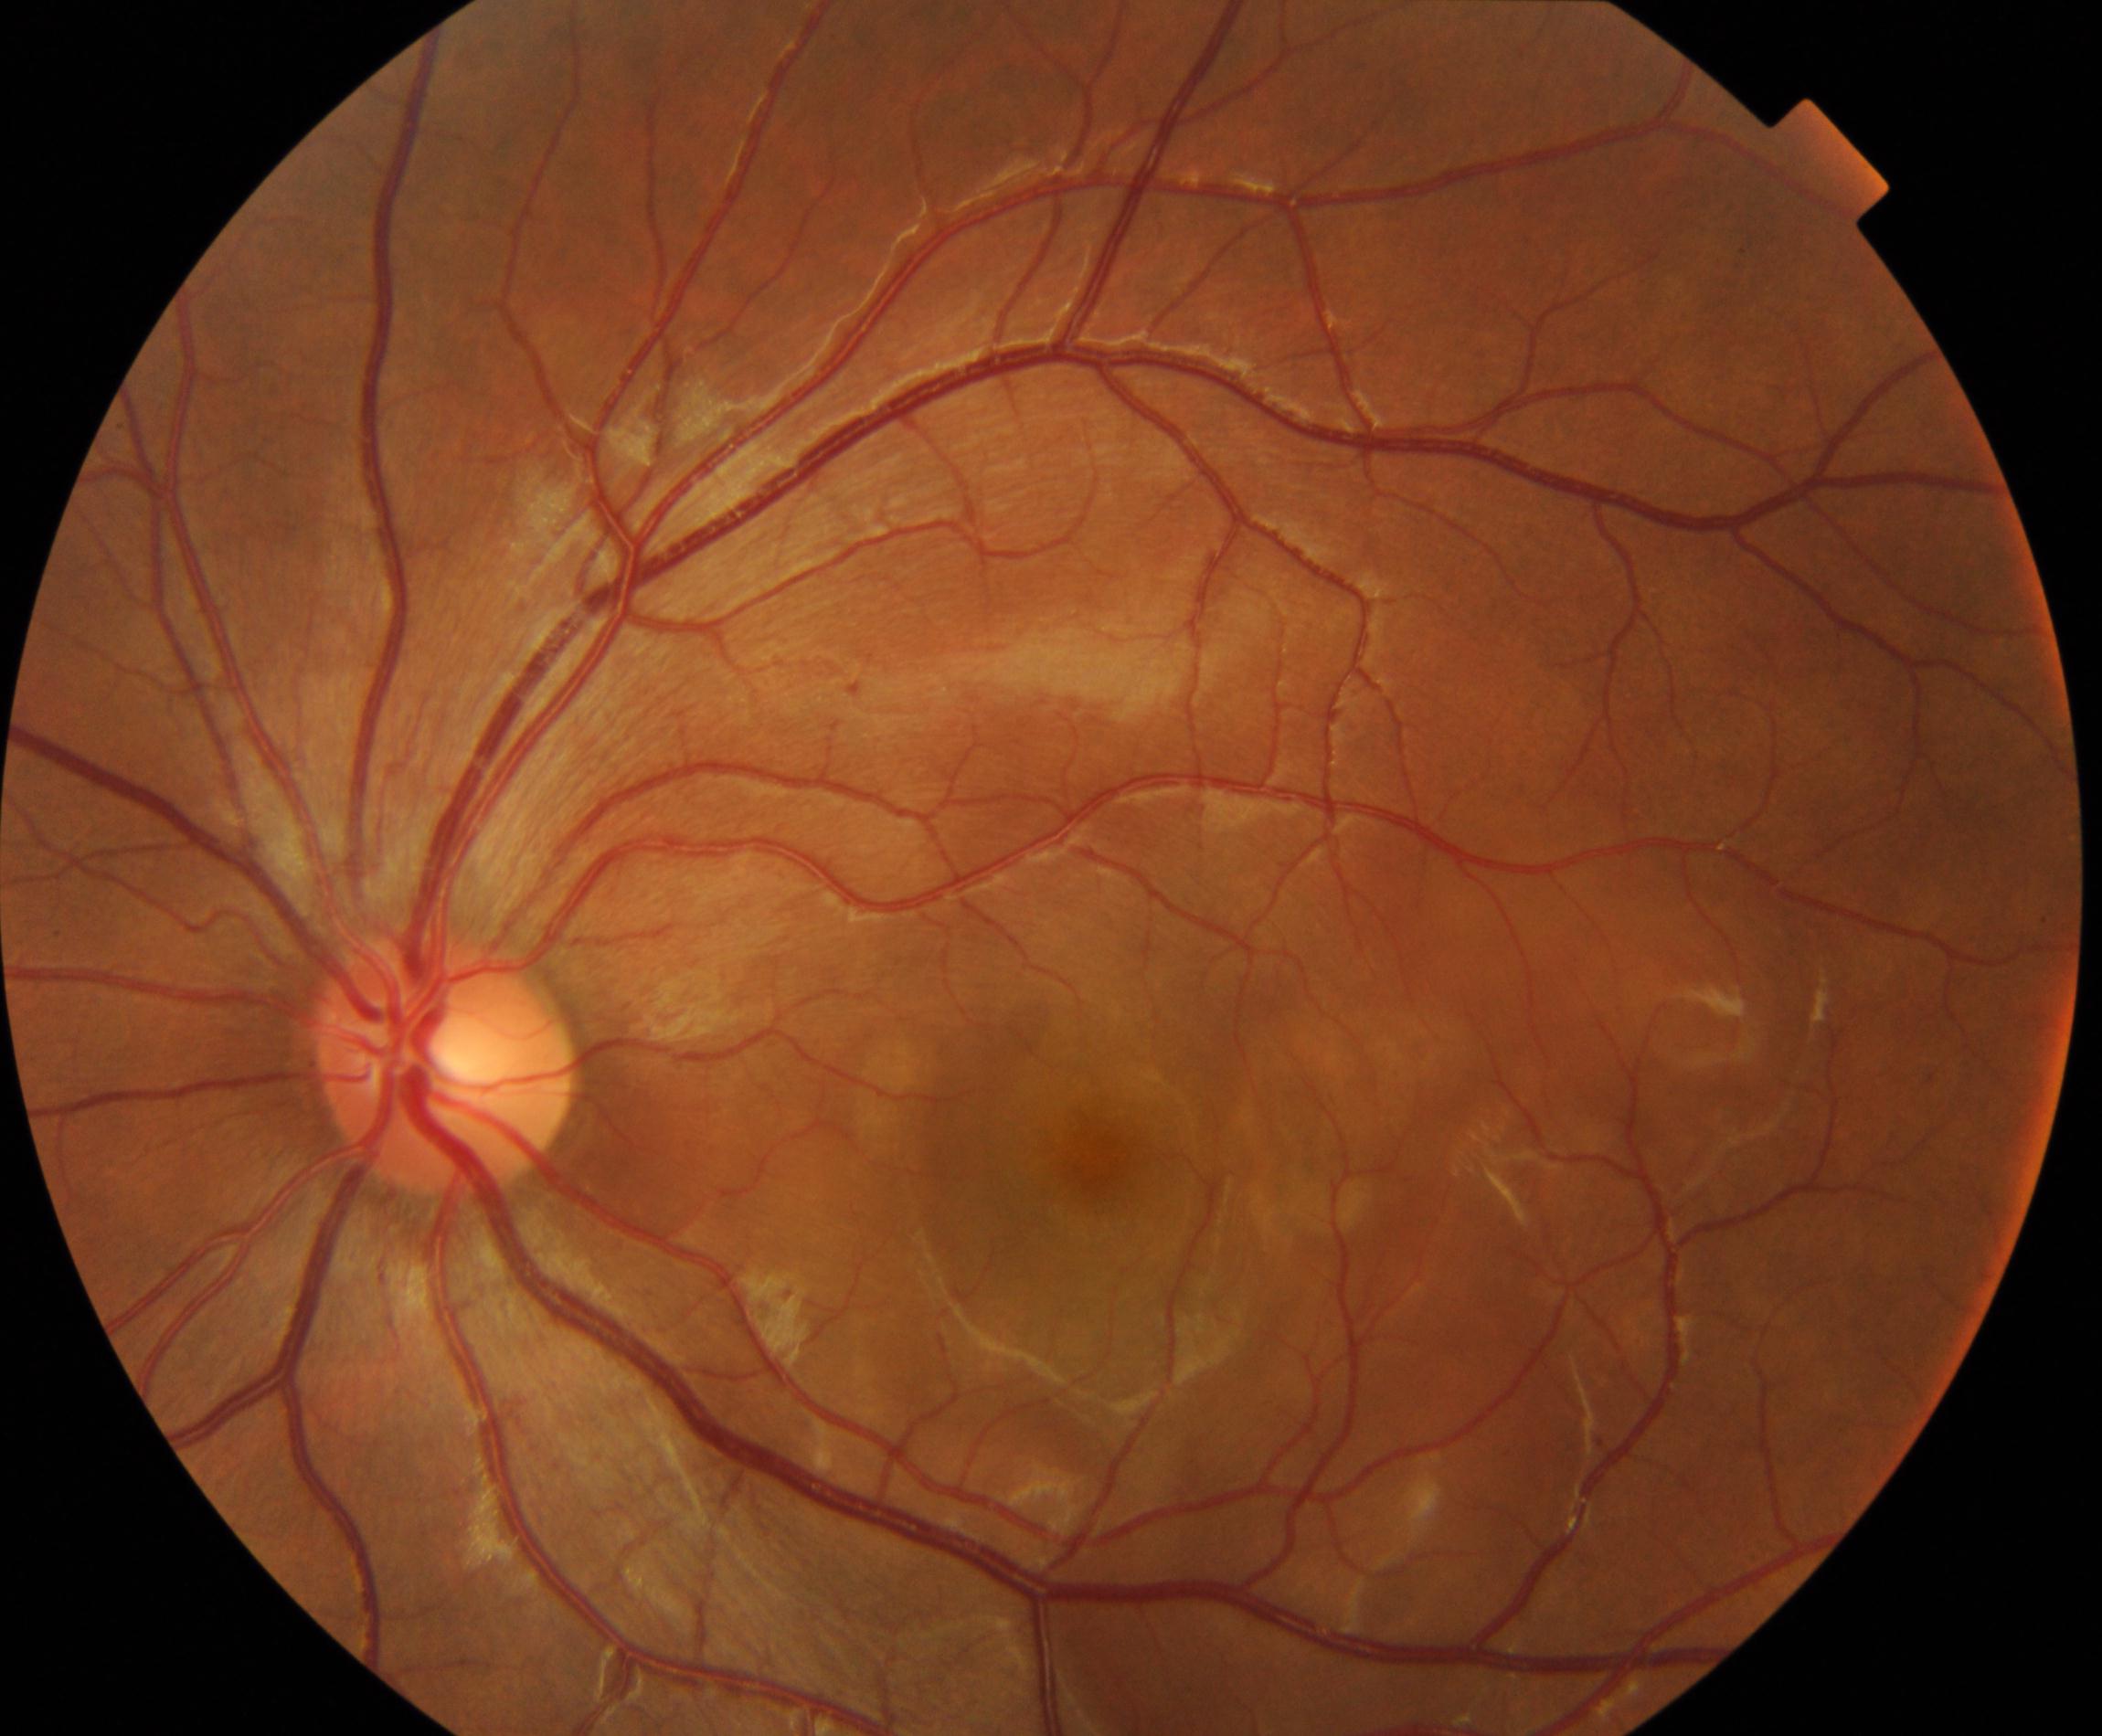
Color fundus photograph showing Vogt-Koyanagi-Harada disease.